Image size 640x480; wide-field contact fundus photograph of an infant; acquired on the Clarity RetCam 3
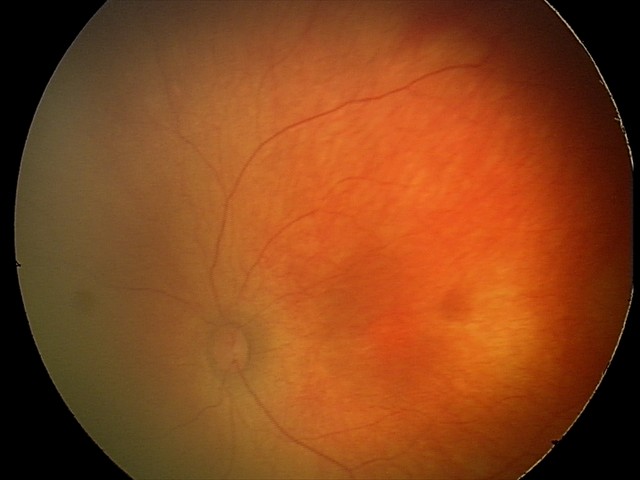

Physiological retinal appearance for postconceptual age.